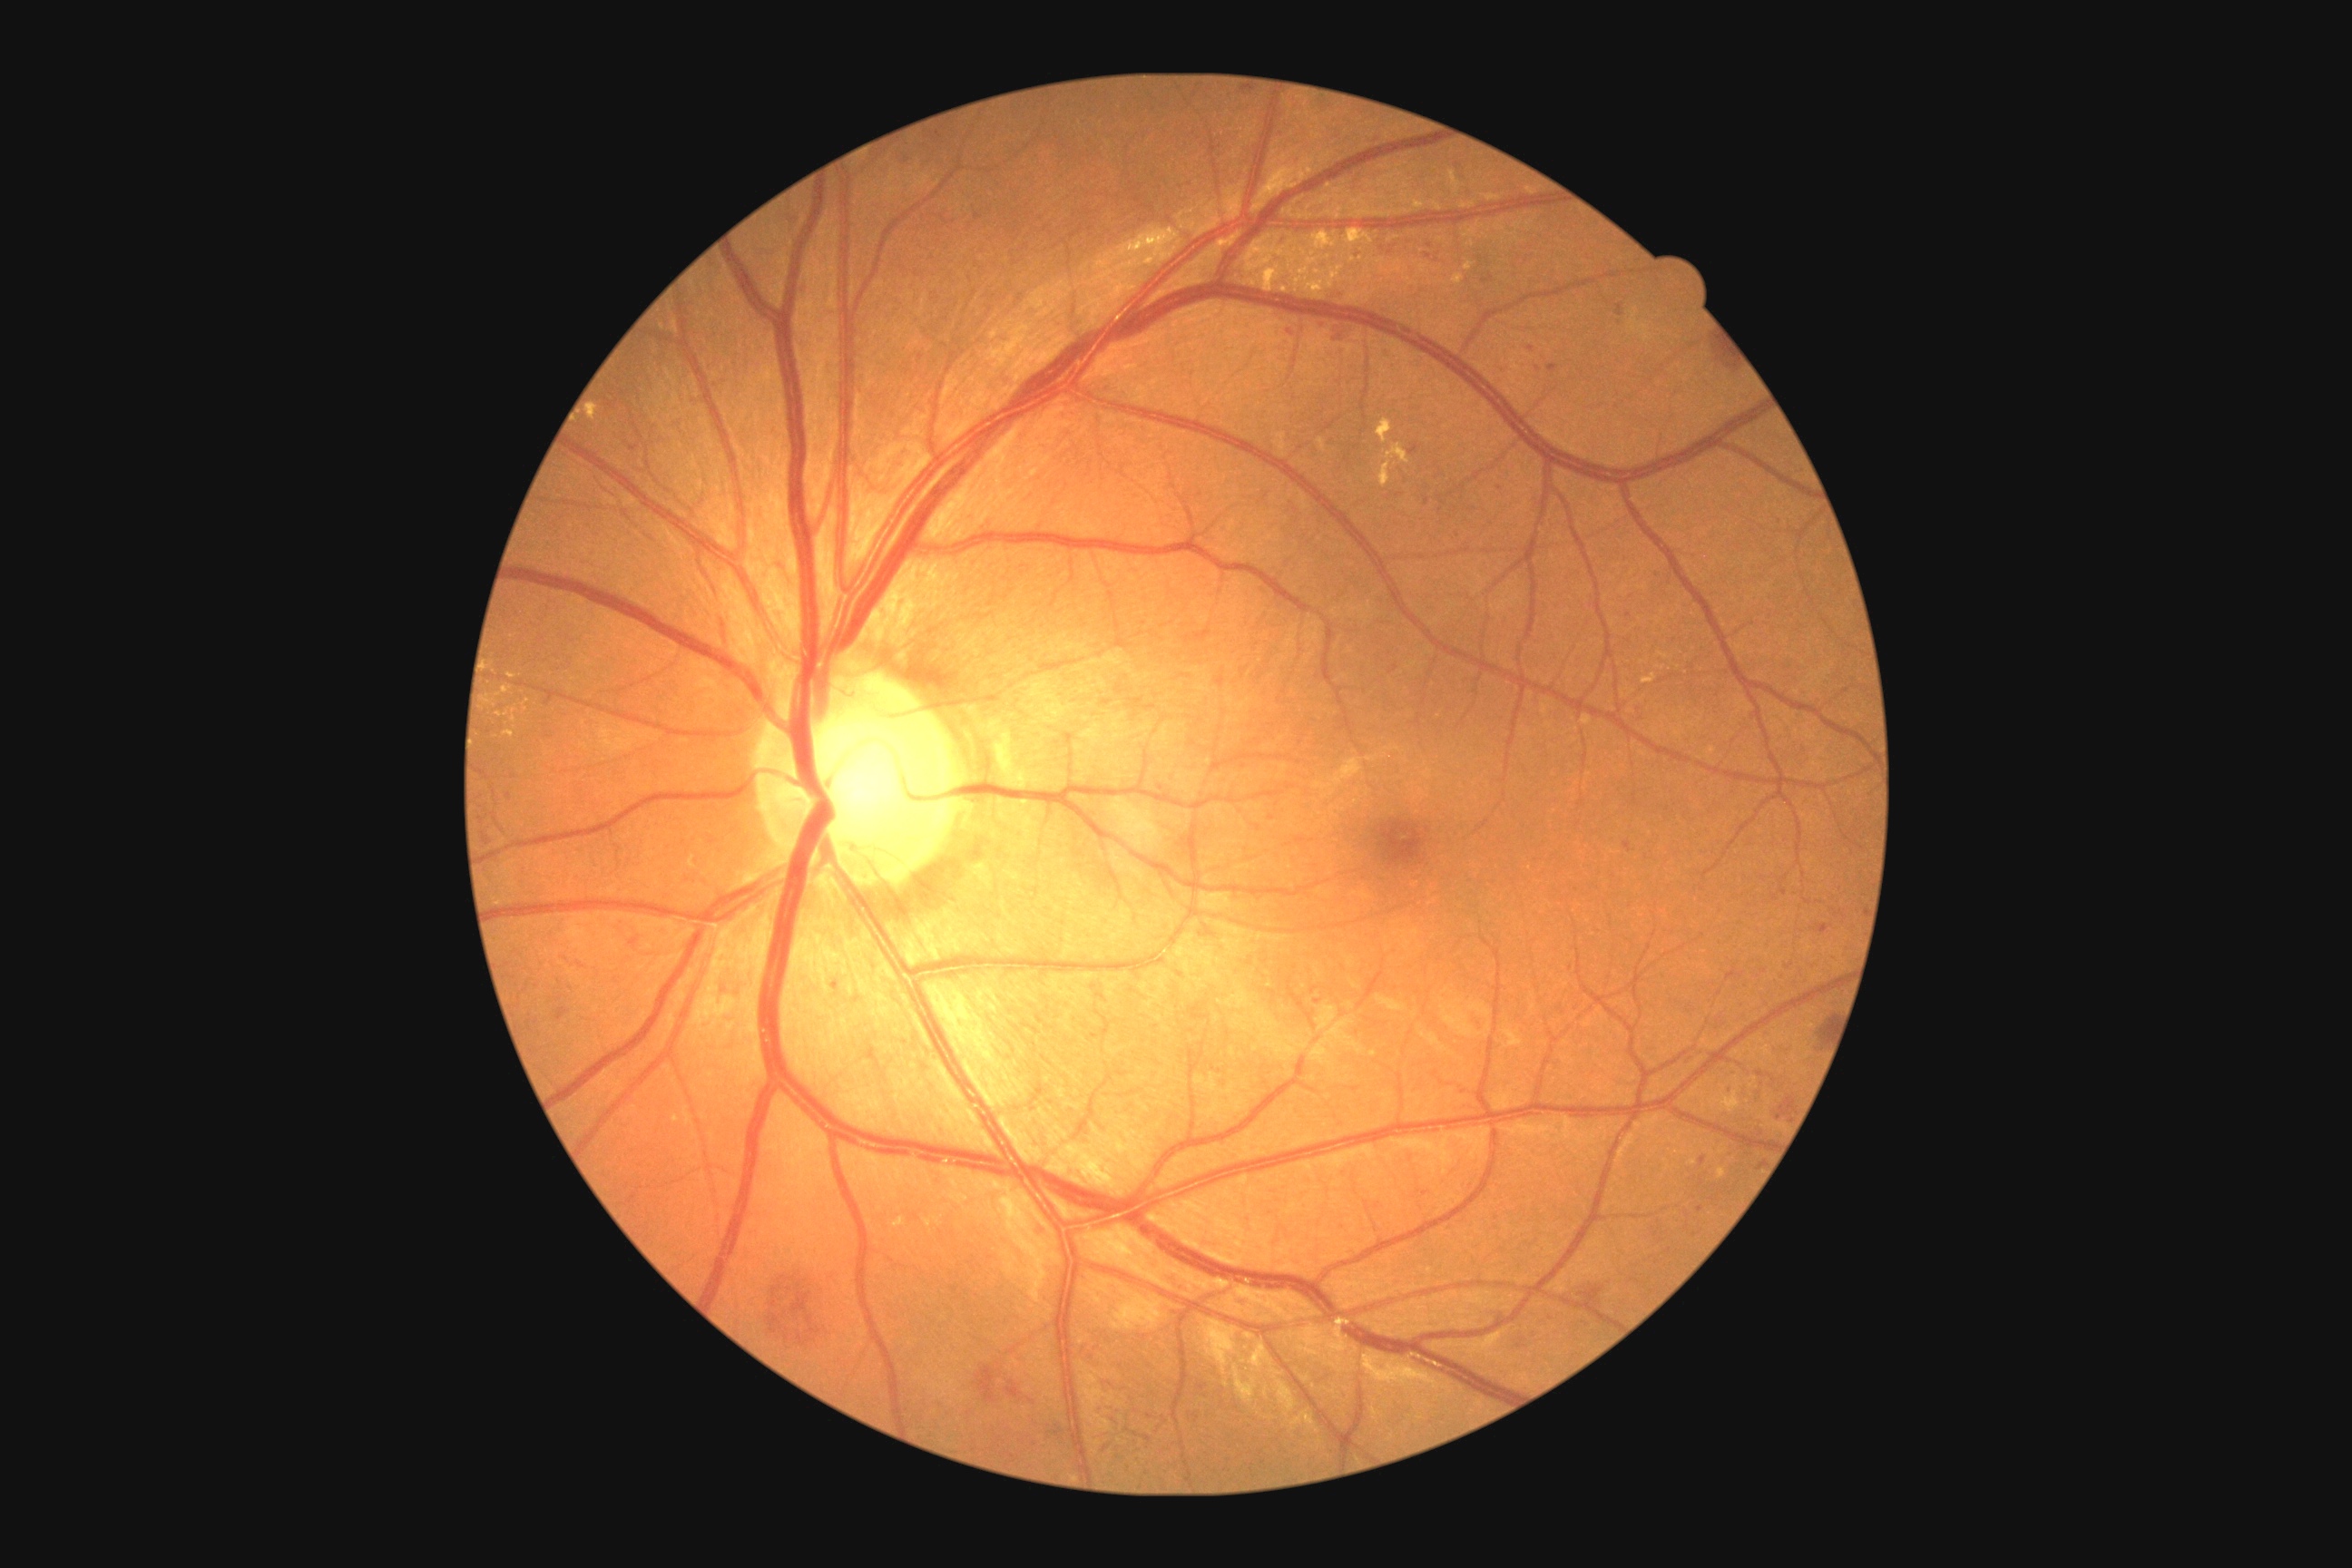

DR: 3/4; non-proliferative diabetic retinopathy
Representative lesions:
SEs: none
HEs (subset): bbox(760, 1268, 845, 1353) | bbox(1783, 961, 1792, 970) | bbox(896, 153, 916, 172) | bbox(1625, 843, 1631, 852) | bbox(1812, 1014, 1836, 1052) | bbox(1456, 188, 1475, 201) | bbox(1277, 235, 1289, 248) | bbox(1364, 133, 1380, 146) | bbox(1426, 239, 1435, 250) | bbox(1375, 239, 1400, 257) | bbox(1380, 348, 1393, 358) | bbox(1293, 157, 1302, 164) | bbox(558, 1008, 567, 1021) | bbox(1758, 968, 1769, 977) | bbox(1494, 375, 1504, 382)
Smaller HEs around (487,841) | (1703,1161) | (1317,1001)
EXs (subset): bbox(1511, 1035, 1520, 1046) | bbox(1393, 447, 1409, 464) | bbox(1458, 199, 1476, 208) | bbox(480, 665, 534, 749) | bbox(1253, 248, 1262, 253) | bbox(1003, 1199, 1023, 1220) | bbox(1300, 270, 1308, 275) | bbox(1480, 193, 1504, 202) | bbox(698, 1012, 701, 1021) | bbox(1309, 282, 1322, 291)
Smaller EXs around (997,1186) | (1419,205) | (1286,289) | (1469,268) | (676,1119) | (1335,276)
MAs: none